Captured with the Natus RetCam Envision (130° field of view). 1440 x 1080 pixels. Infant wide-field fundus photograph: 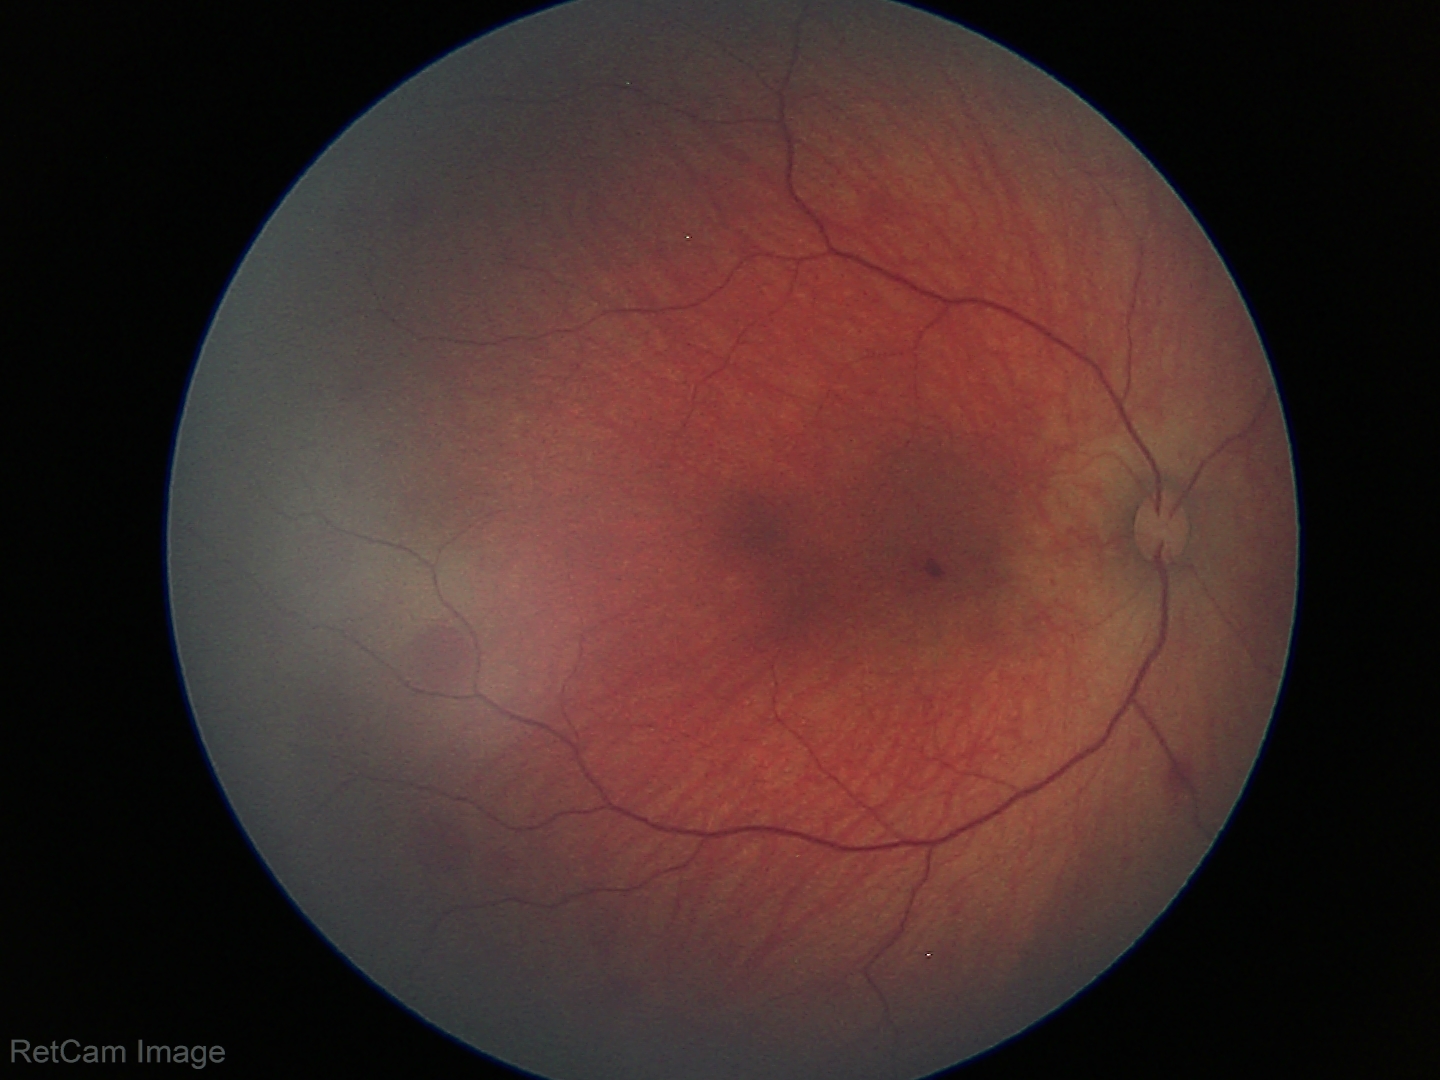
Diagnosis: retinal hemorrhages.